Acquired on the Natus RetCam Envision. Infant wide-field fundus photograph — 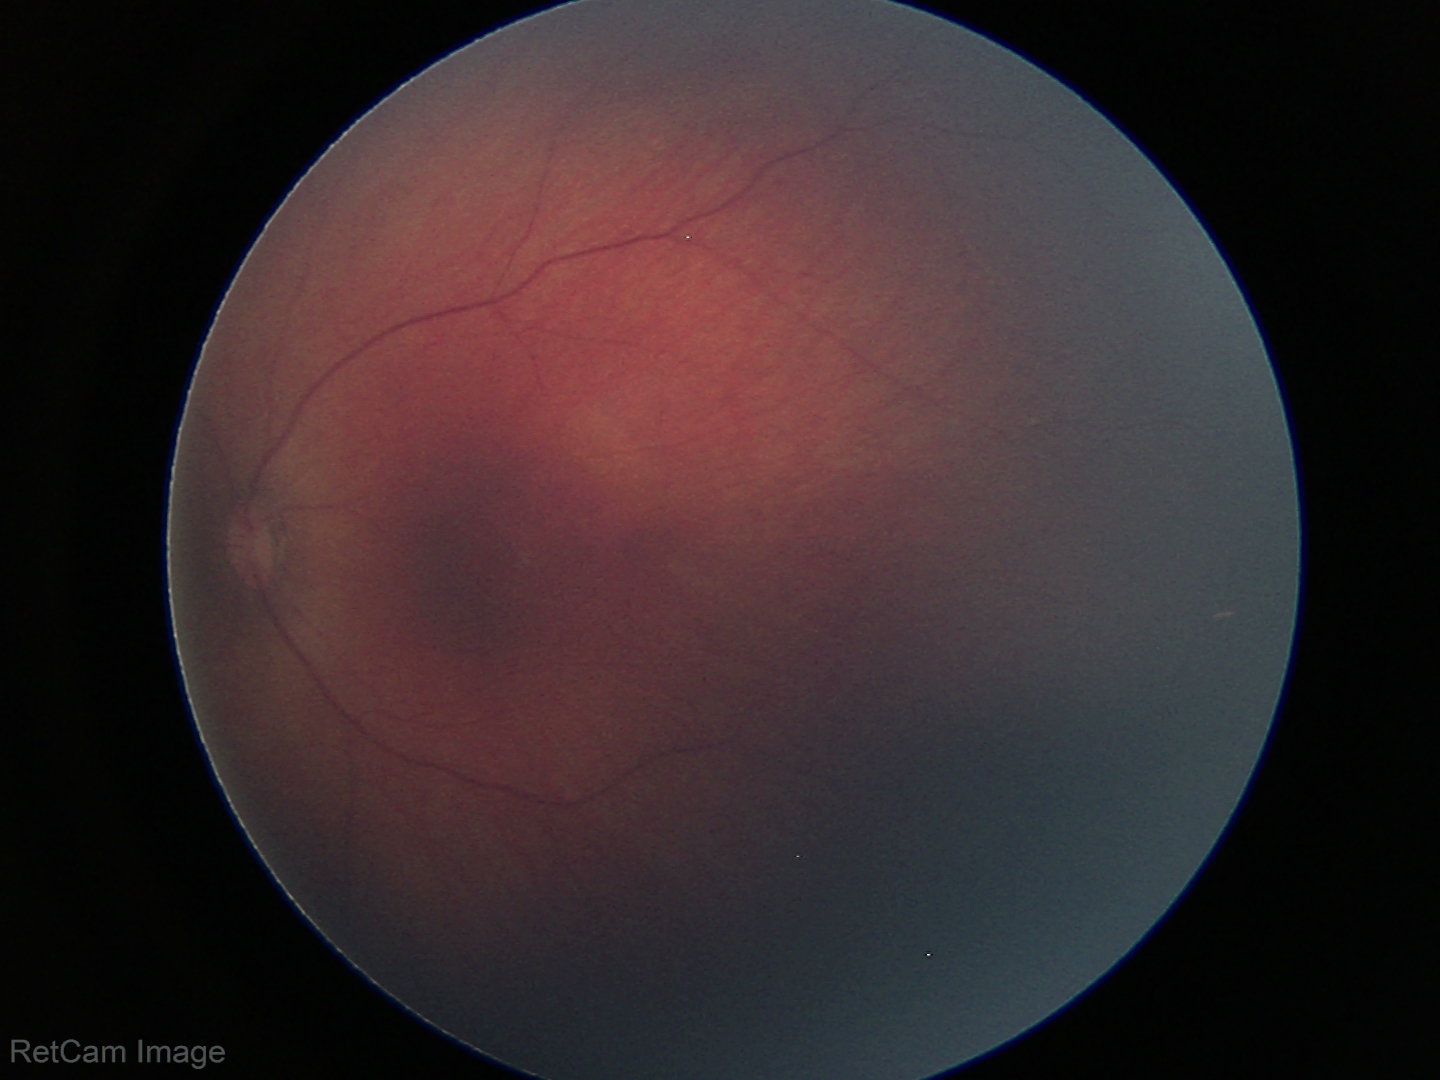 Physiological retinal appearance for postconceptual age.